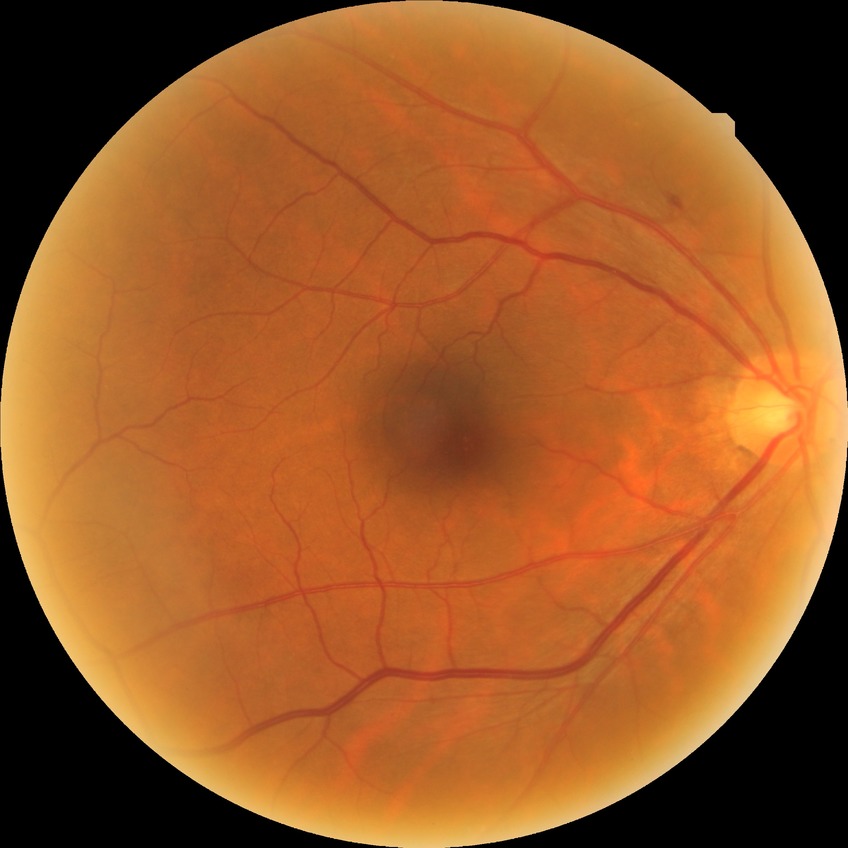

Findings:
– Davis grade: SDR